Camera: NIDEK AFC-230 · 45 degree fundus photograph · CFP · 848 x 848 pixels · nonmydriatic fundus photograph: 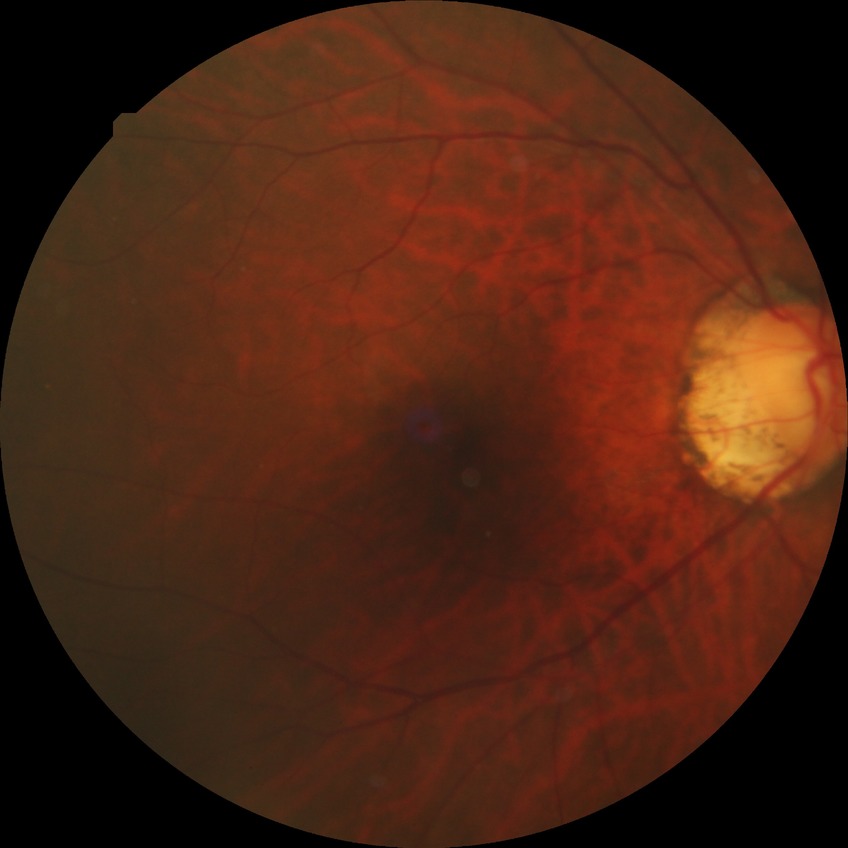

Diabetic retinopathy (DR) is NDR (no diabetic retinopathy).